2048 x 1536 pixels; CFP — 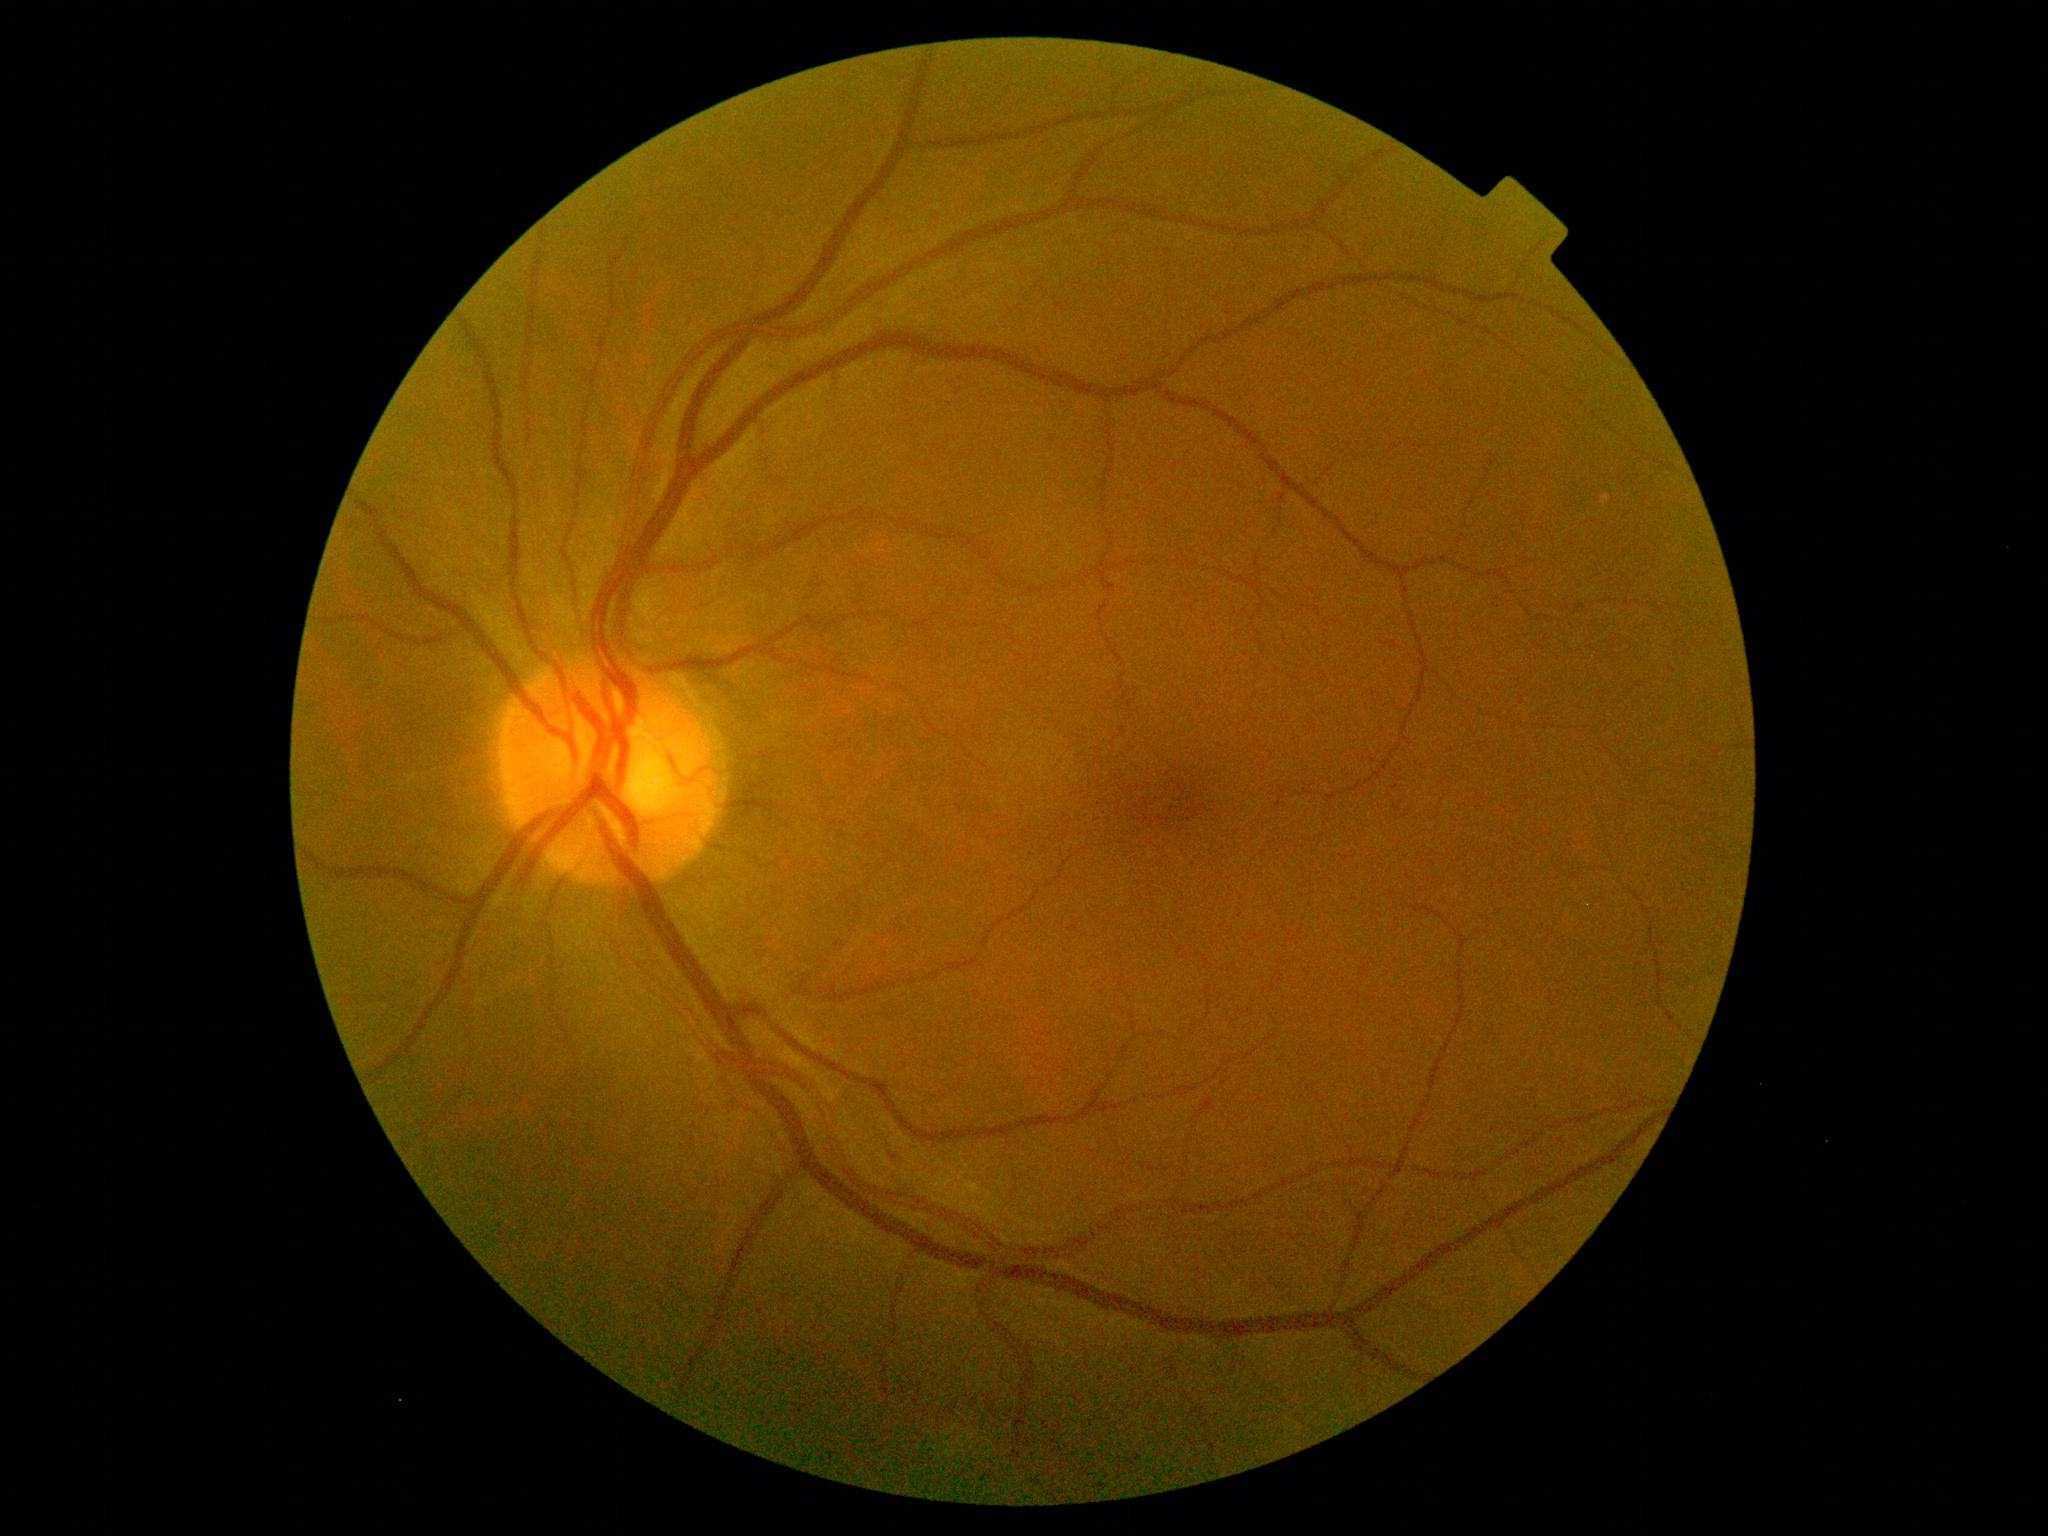
* diabetic retinopathy (DR) — 1